CFP
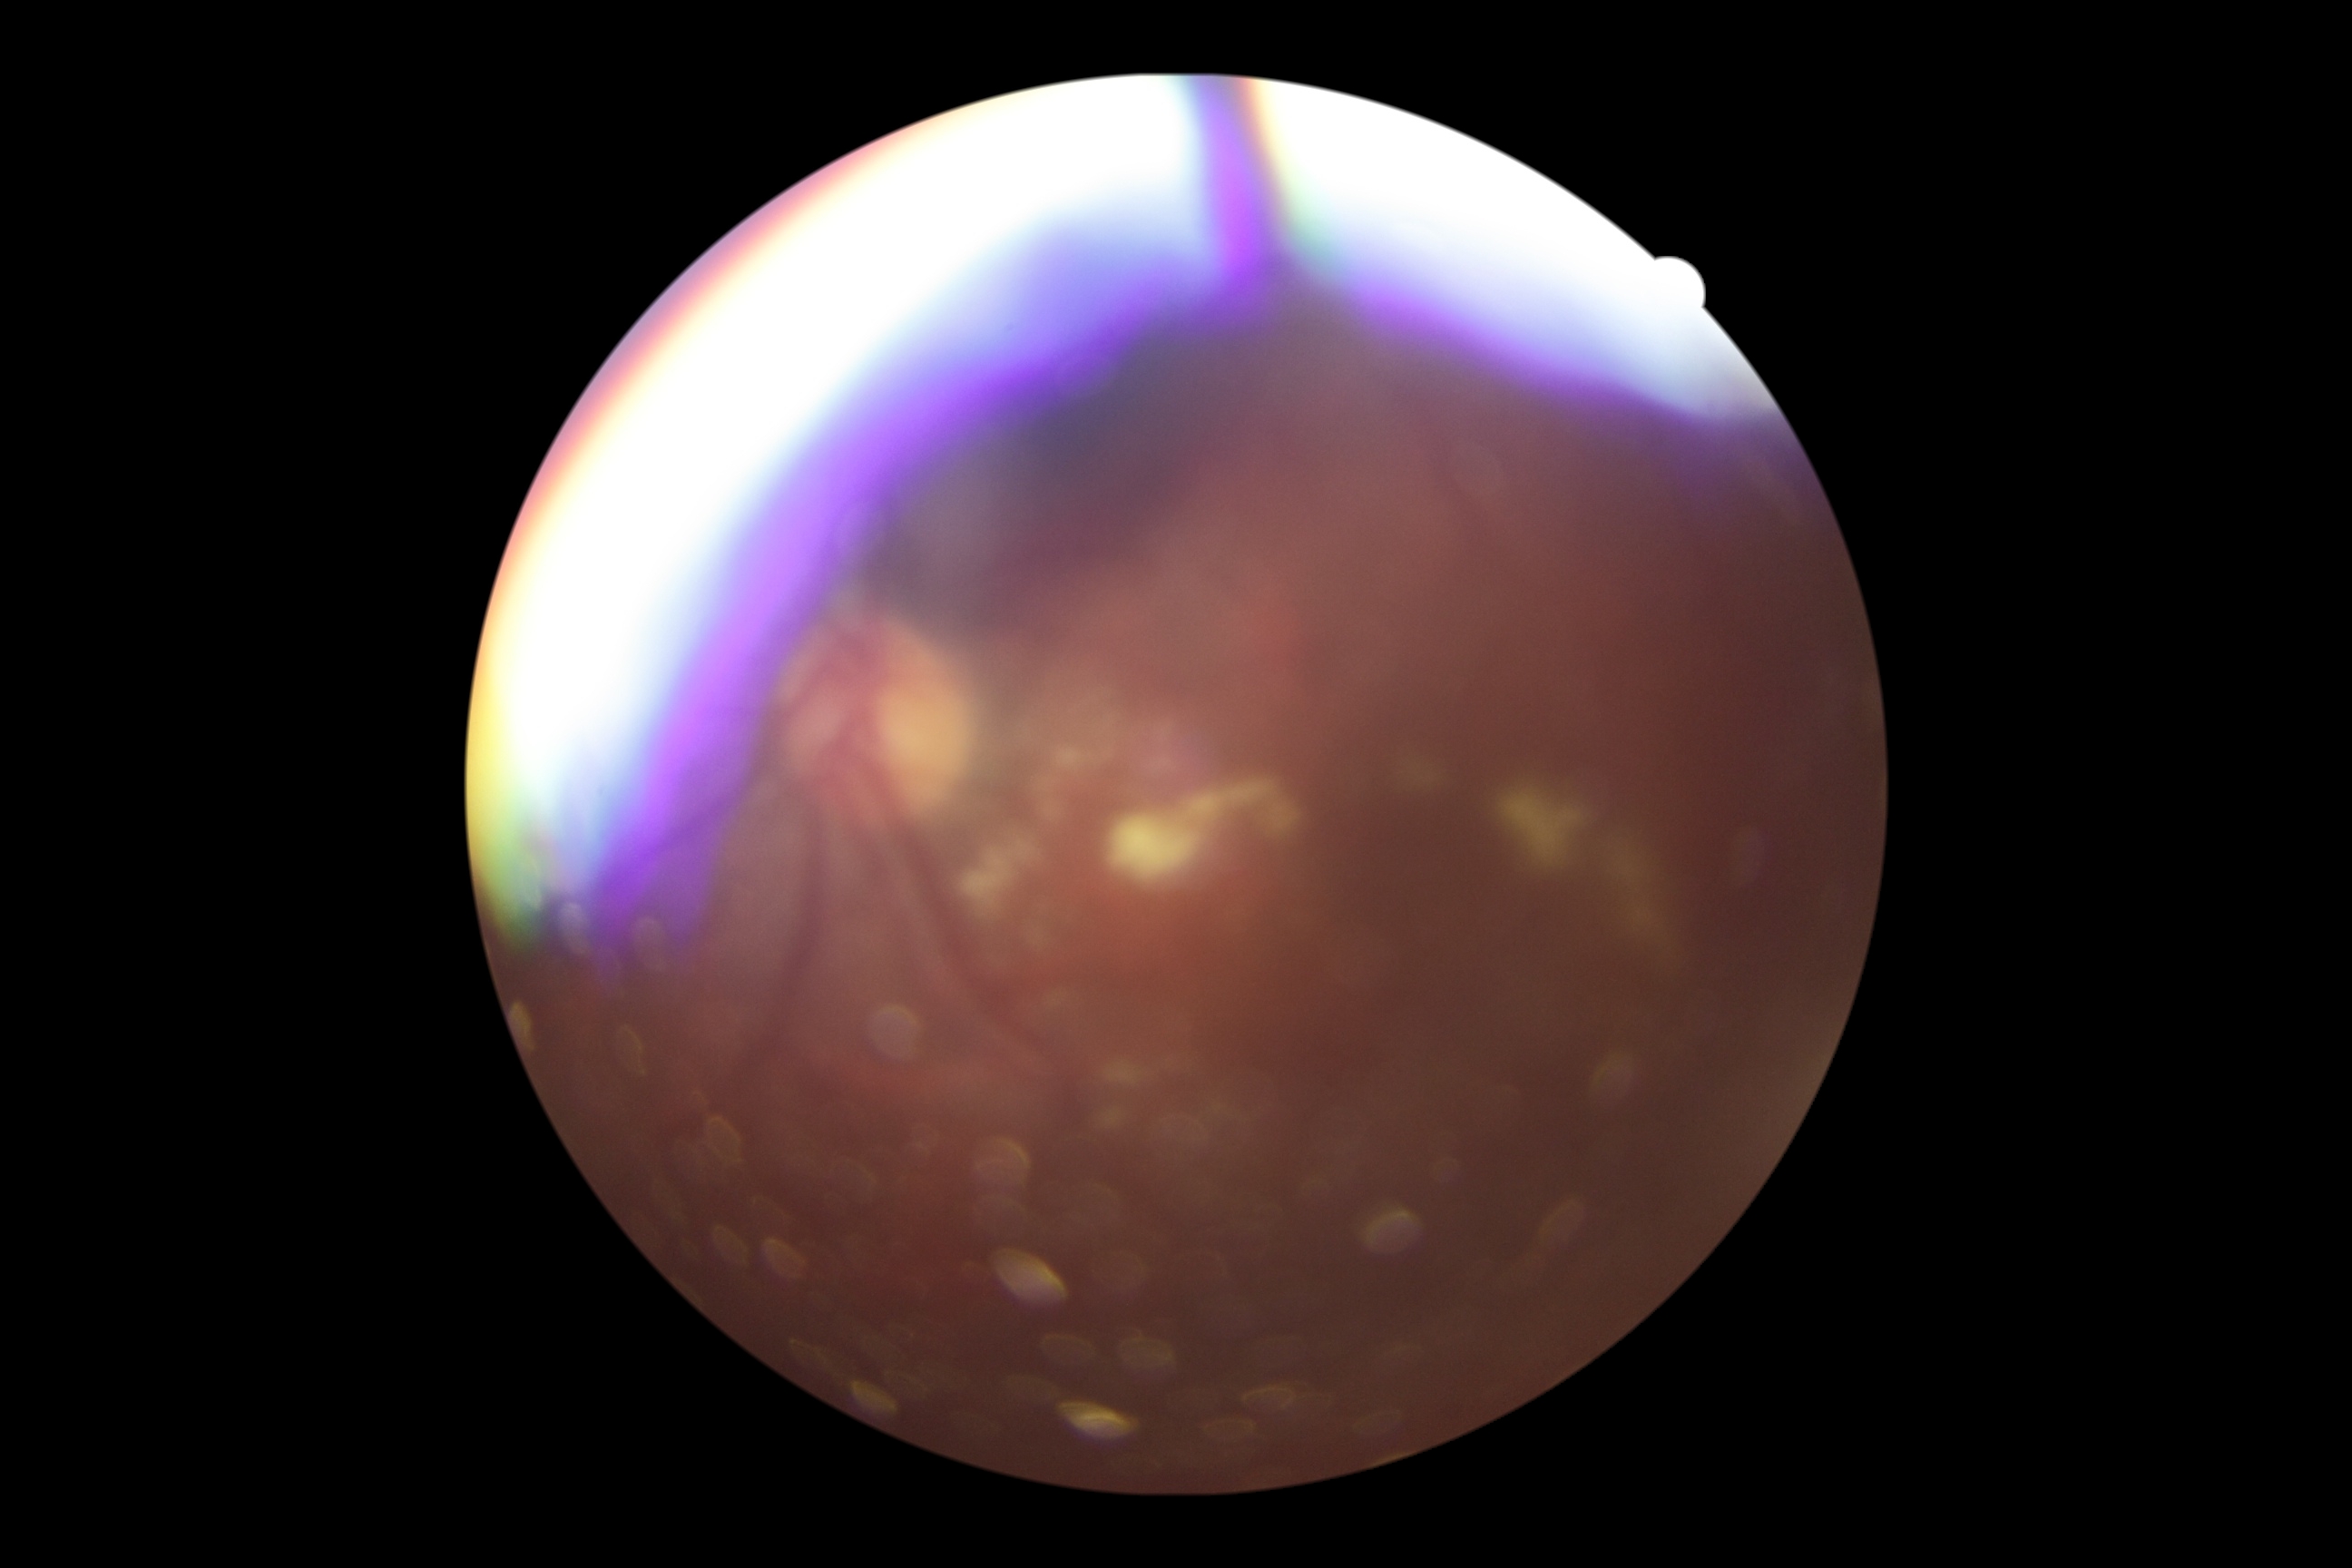
Diabetic retinopathy (DR) is moderate non-proliferative diabetic retinopathy (grade 2).